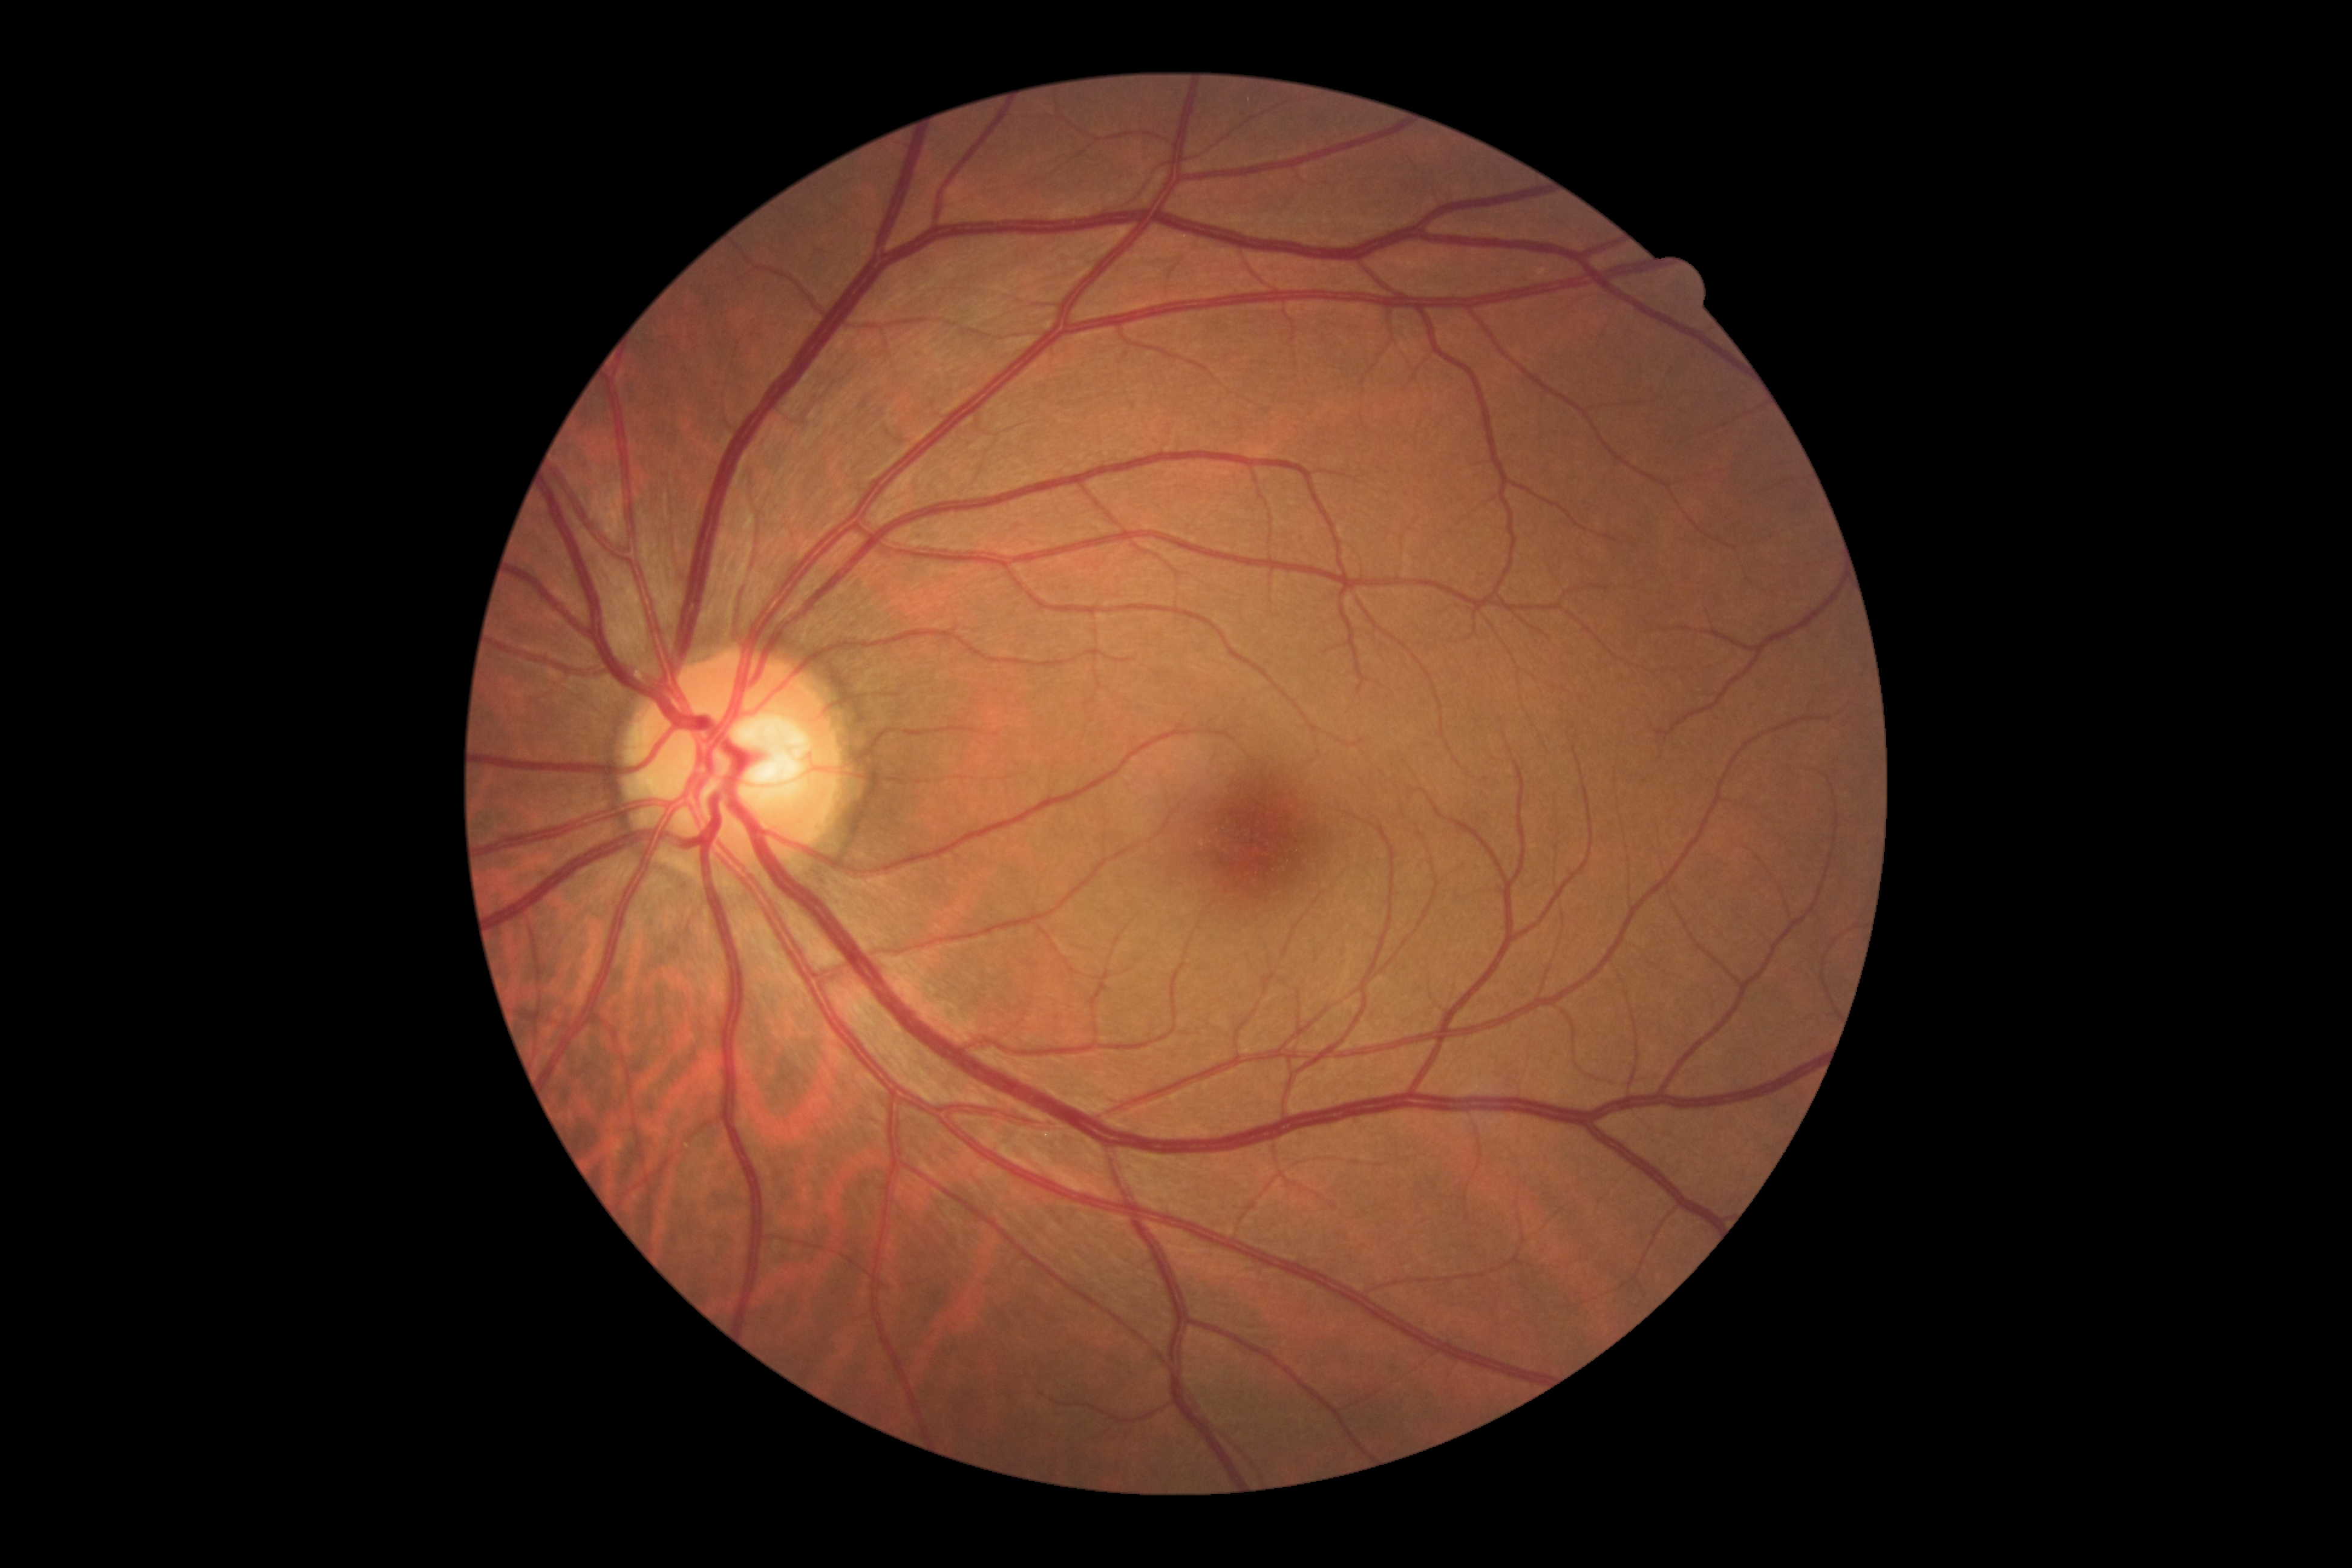 DR severity is grade 0 (no apparent retinopathy).